Camera: Forus 3Nethra Classic fundus camera · 2048 x 1536 pixels · color fundus photograph:
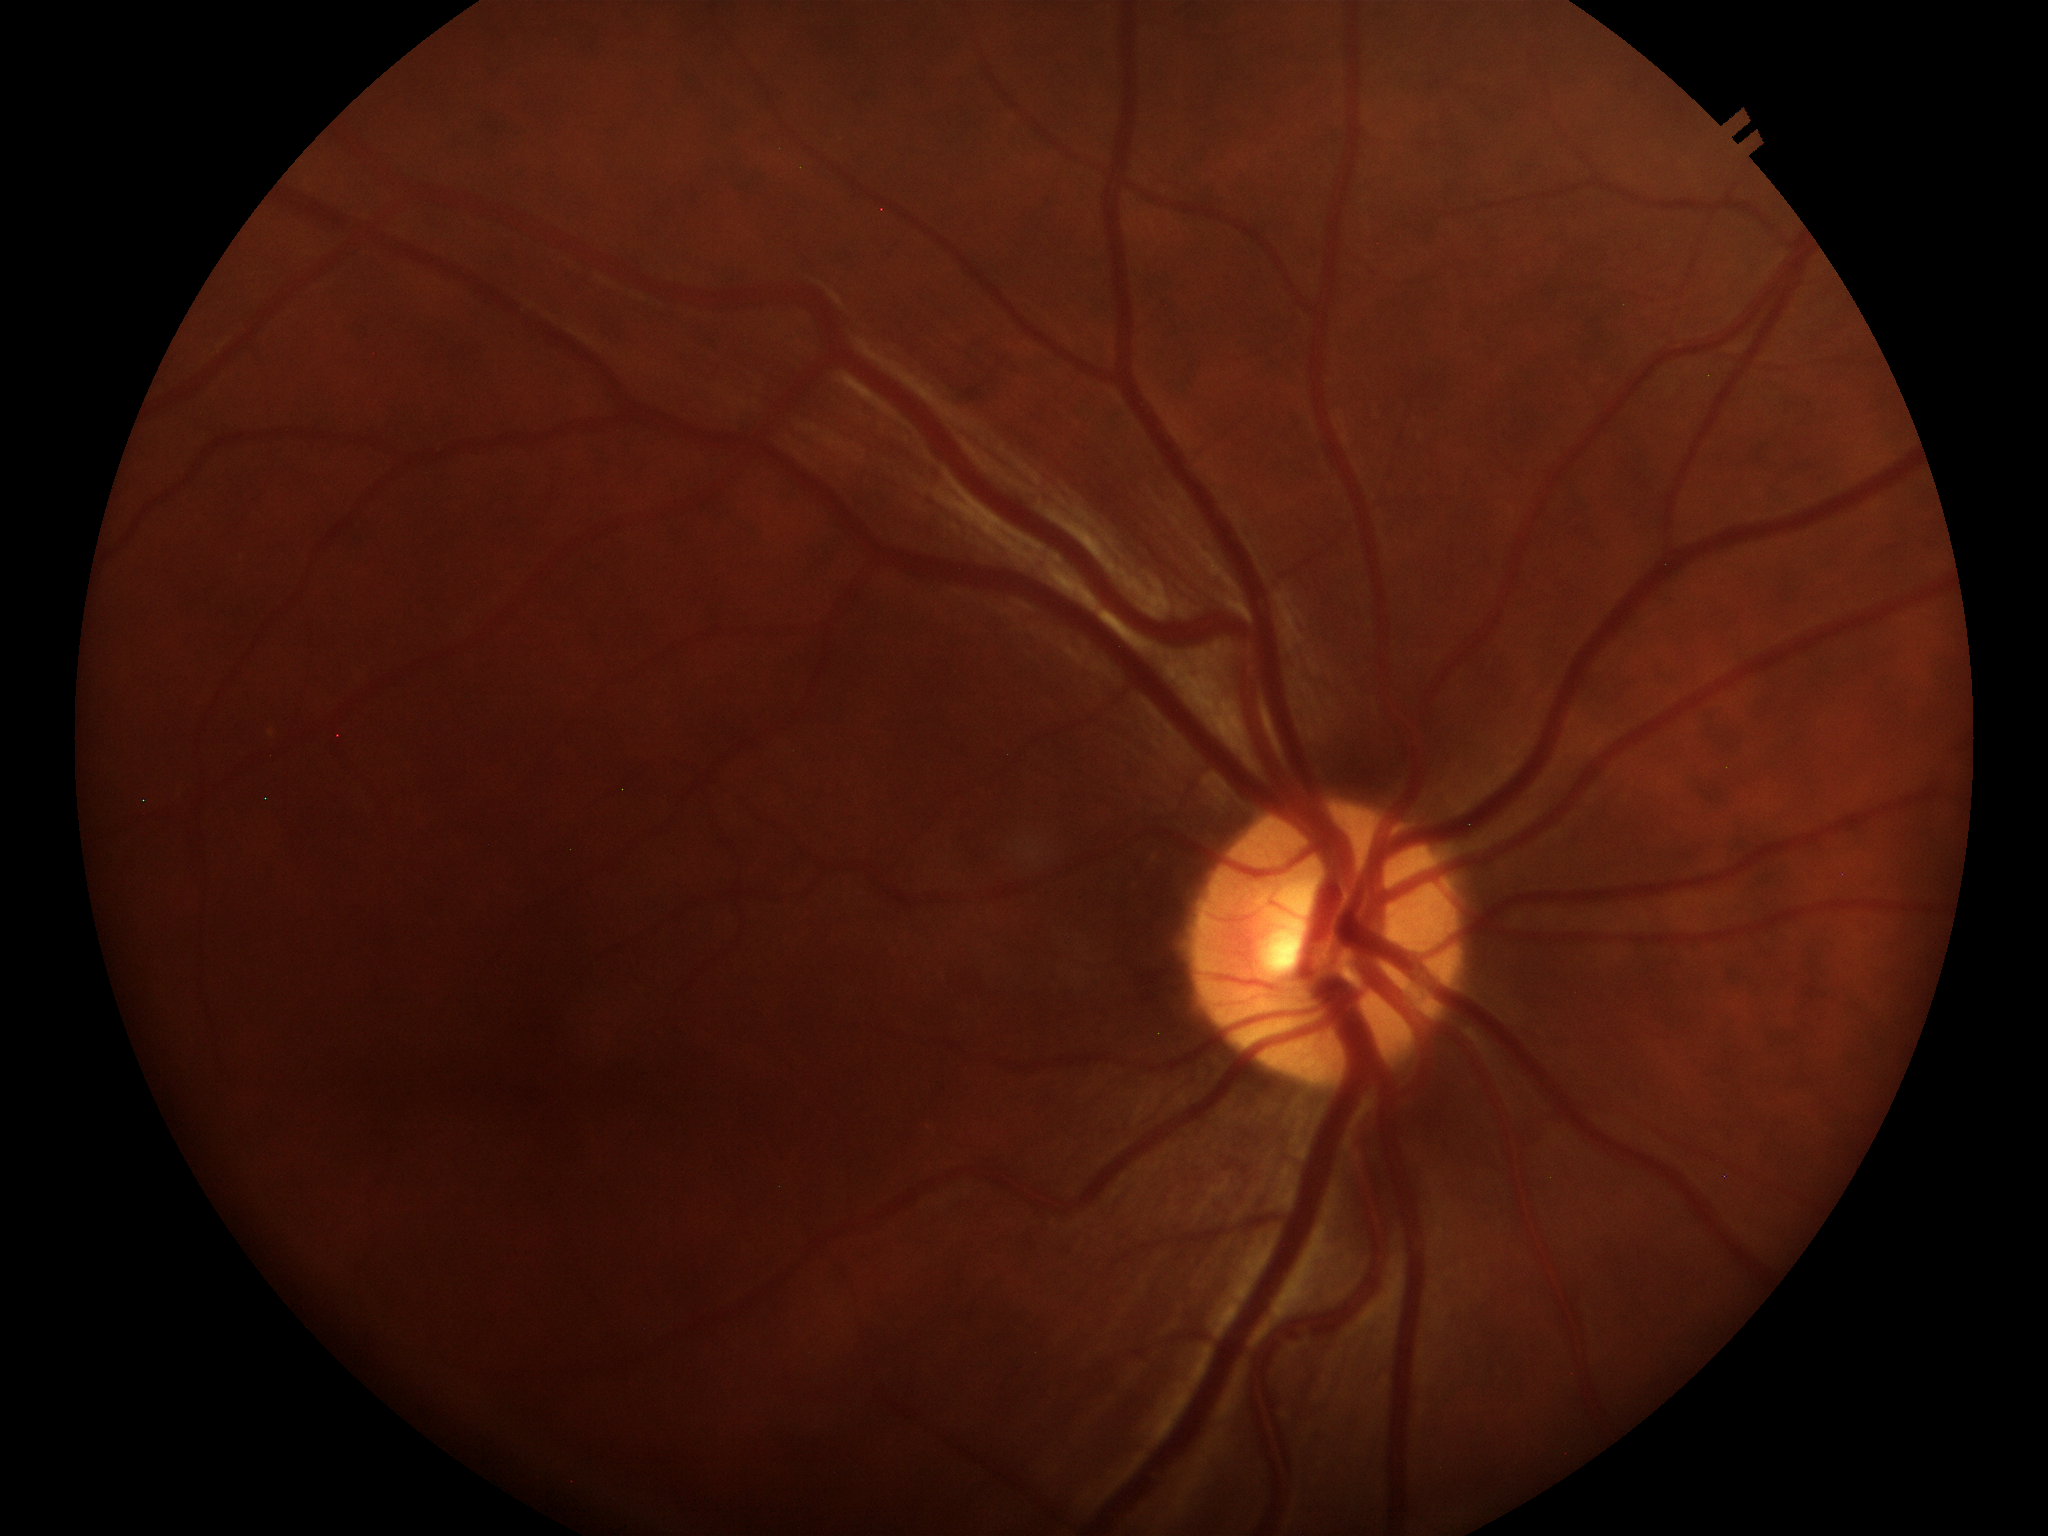

Vertical C/D ratio (VCDR) of 0.49. Glaucoma screening: not suspect (one of five ophthalmologists flagged glaucoma suspect).